Diabetic retinopathy graded by the modified Davis classification: 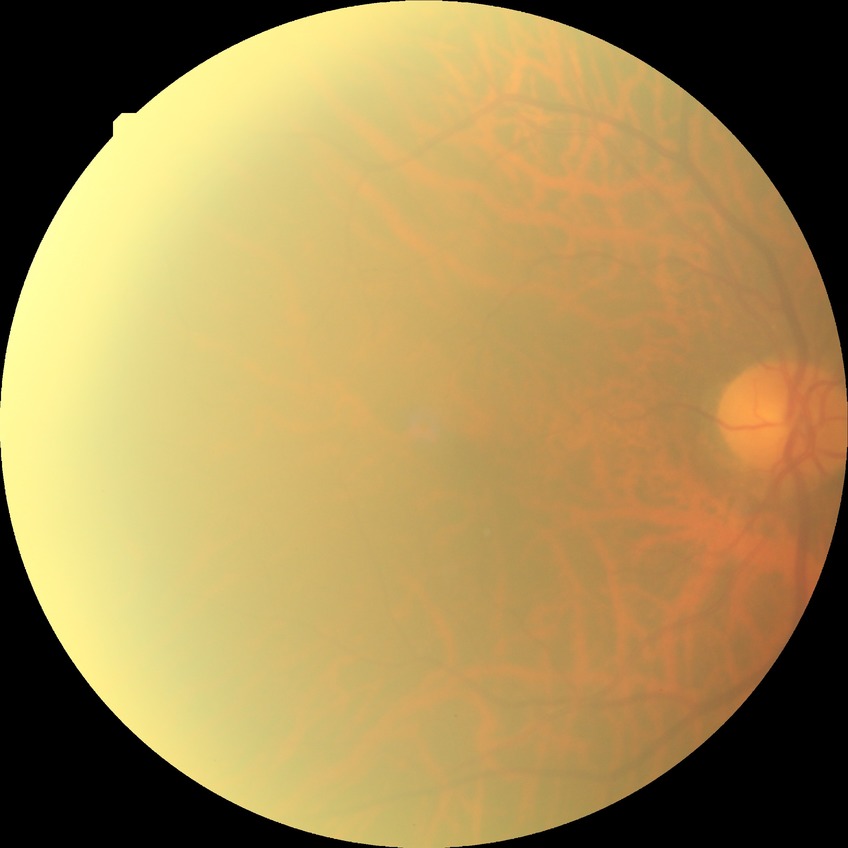

diabetic retinopathy grade = no diabetic retinopathy.